Ultra-widefield fundus mosaic, 1924 x 1556 pixels
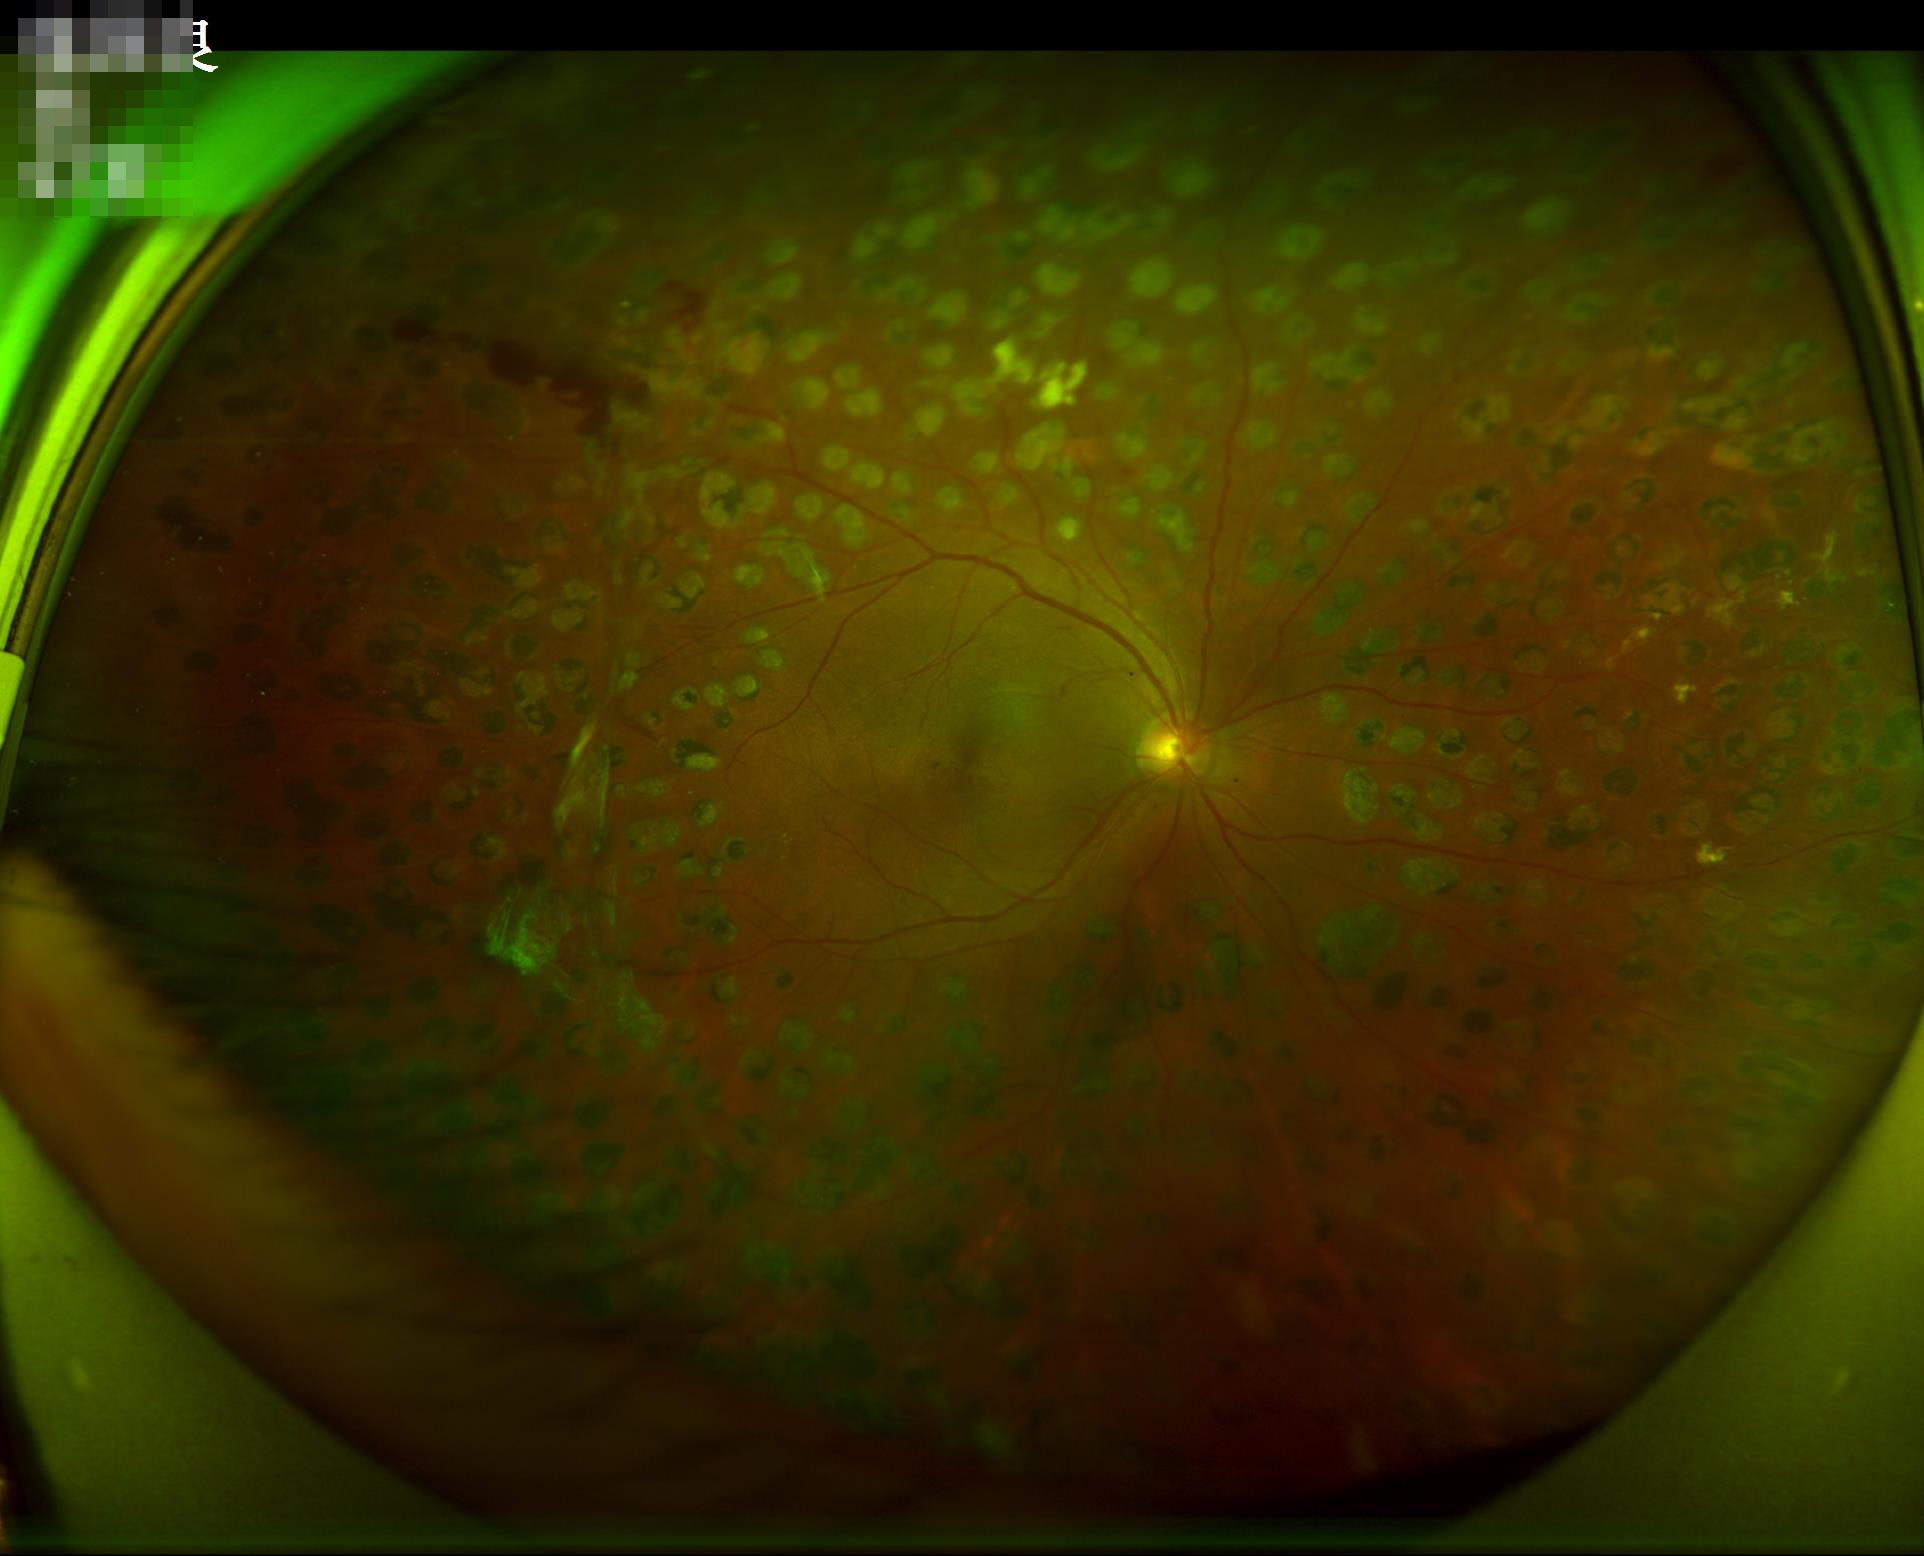

Image quality is adequate for diagnostic use. Adequate contrast for distinguishing structures.